Acquired with a NIDEK AFC-230:
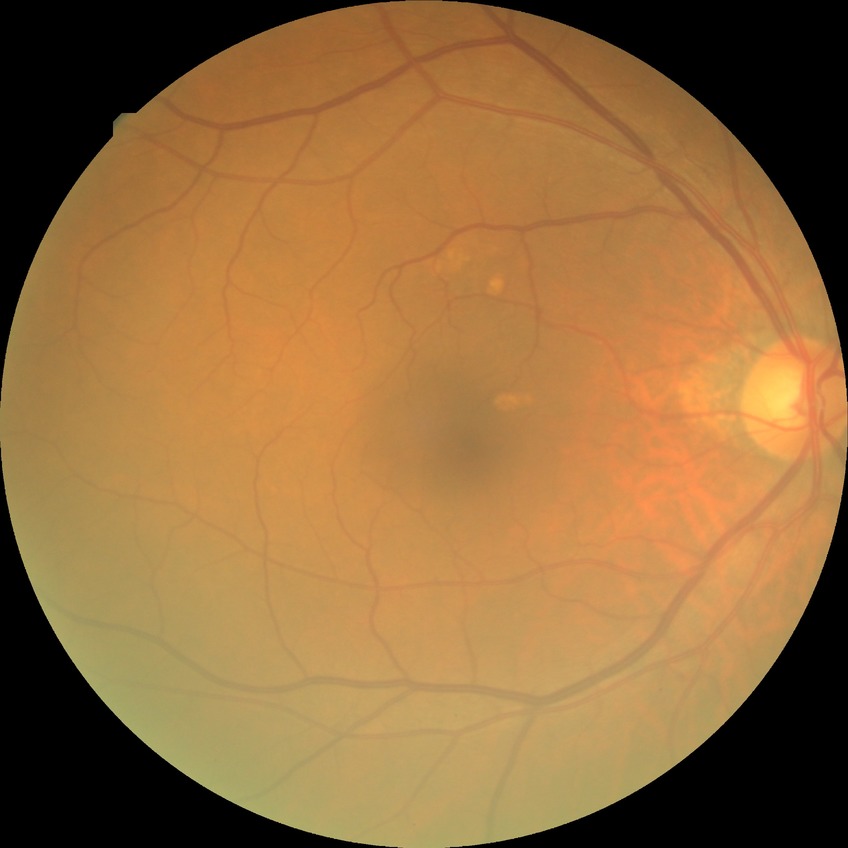
Findings:
* diabetic retinopathy (DR) — no diabetic retinopathy (NDR)